Image size 1240x1240. Wide-field contact fundus photograph of an infant. Acquired on the Phoenix ICON: 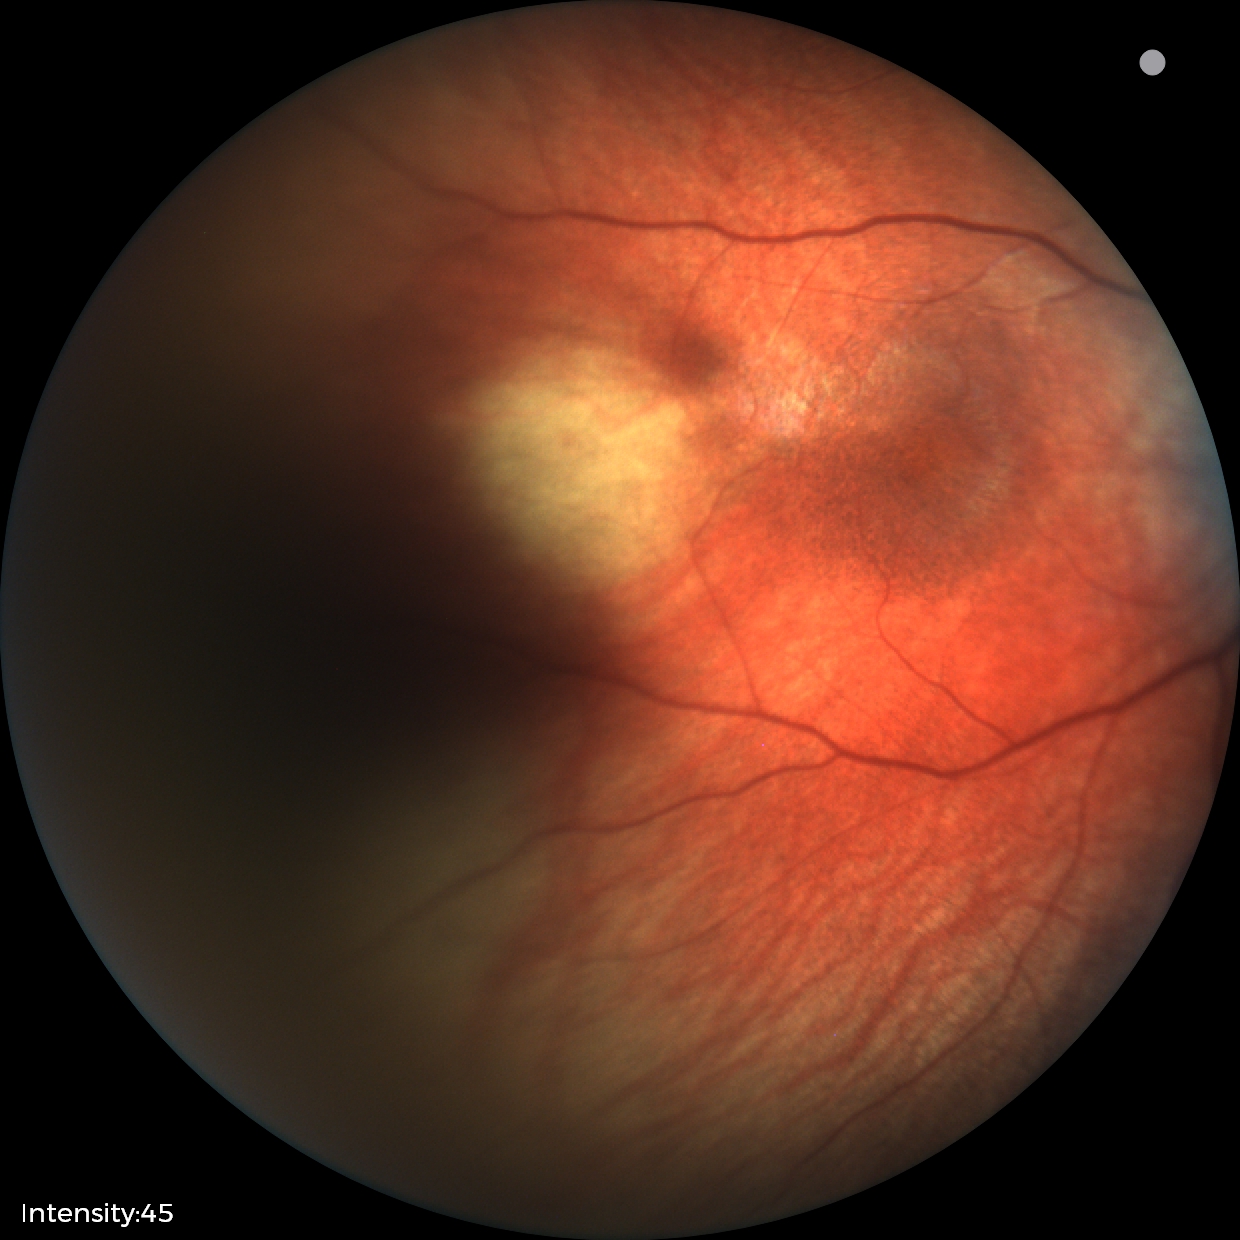

Q: What was the screening finding?
A: physiological retinal finding